Color fundus photograph.
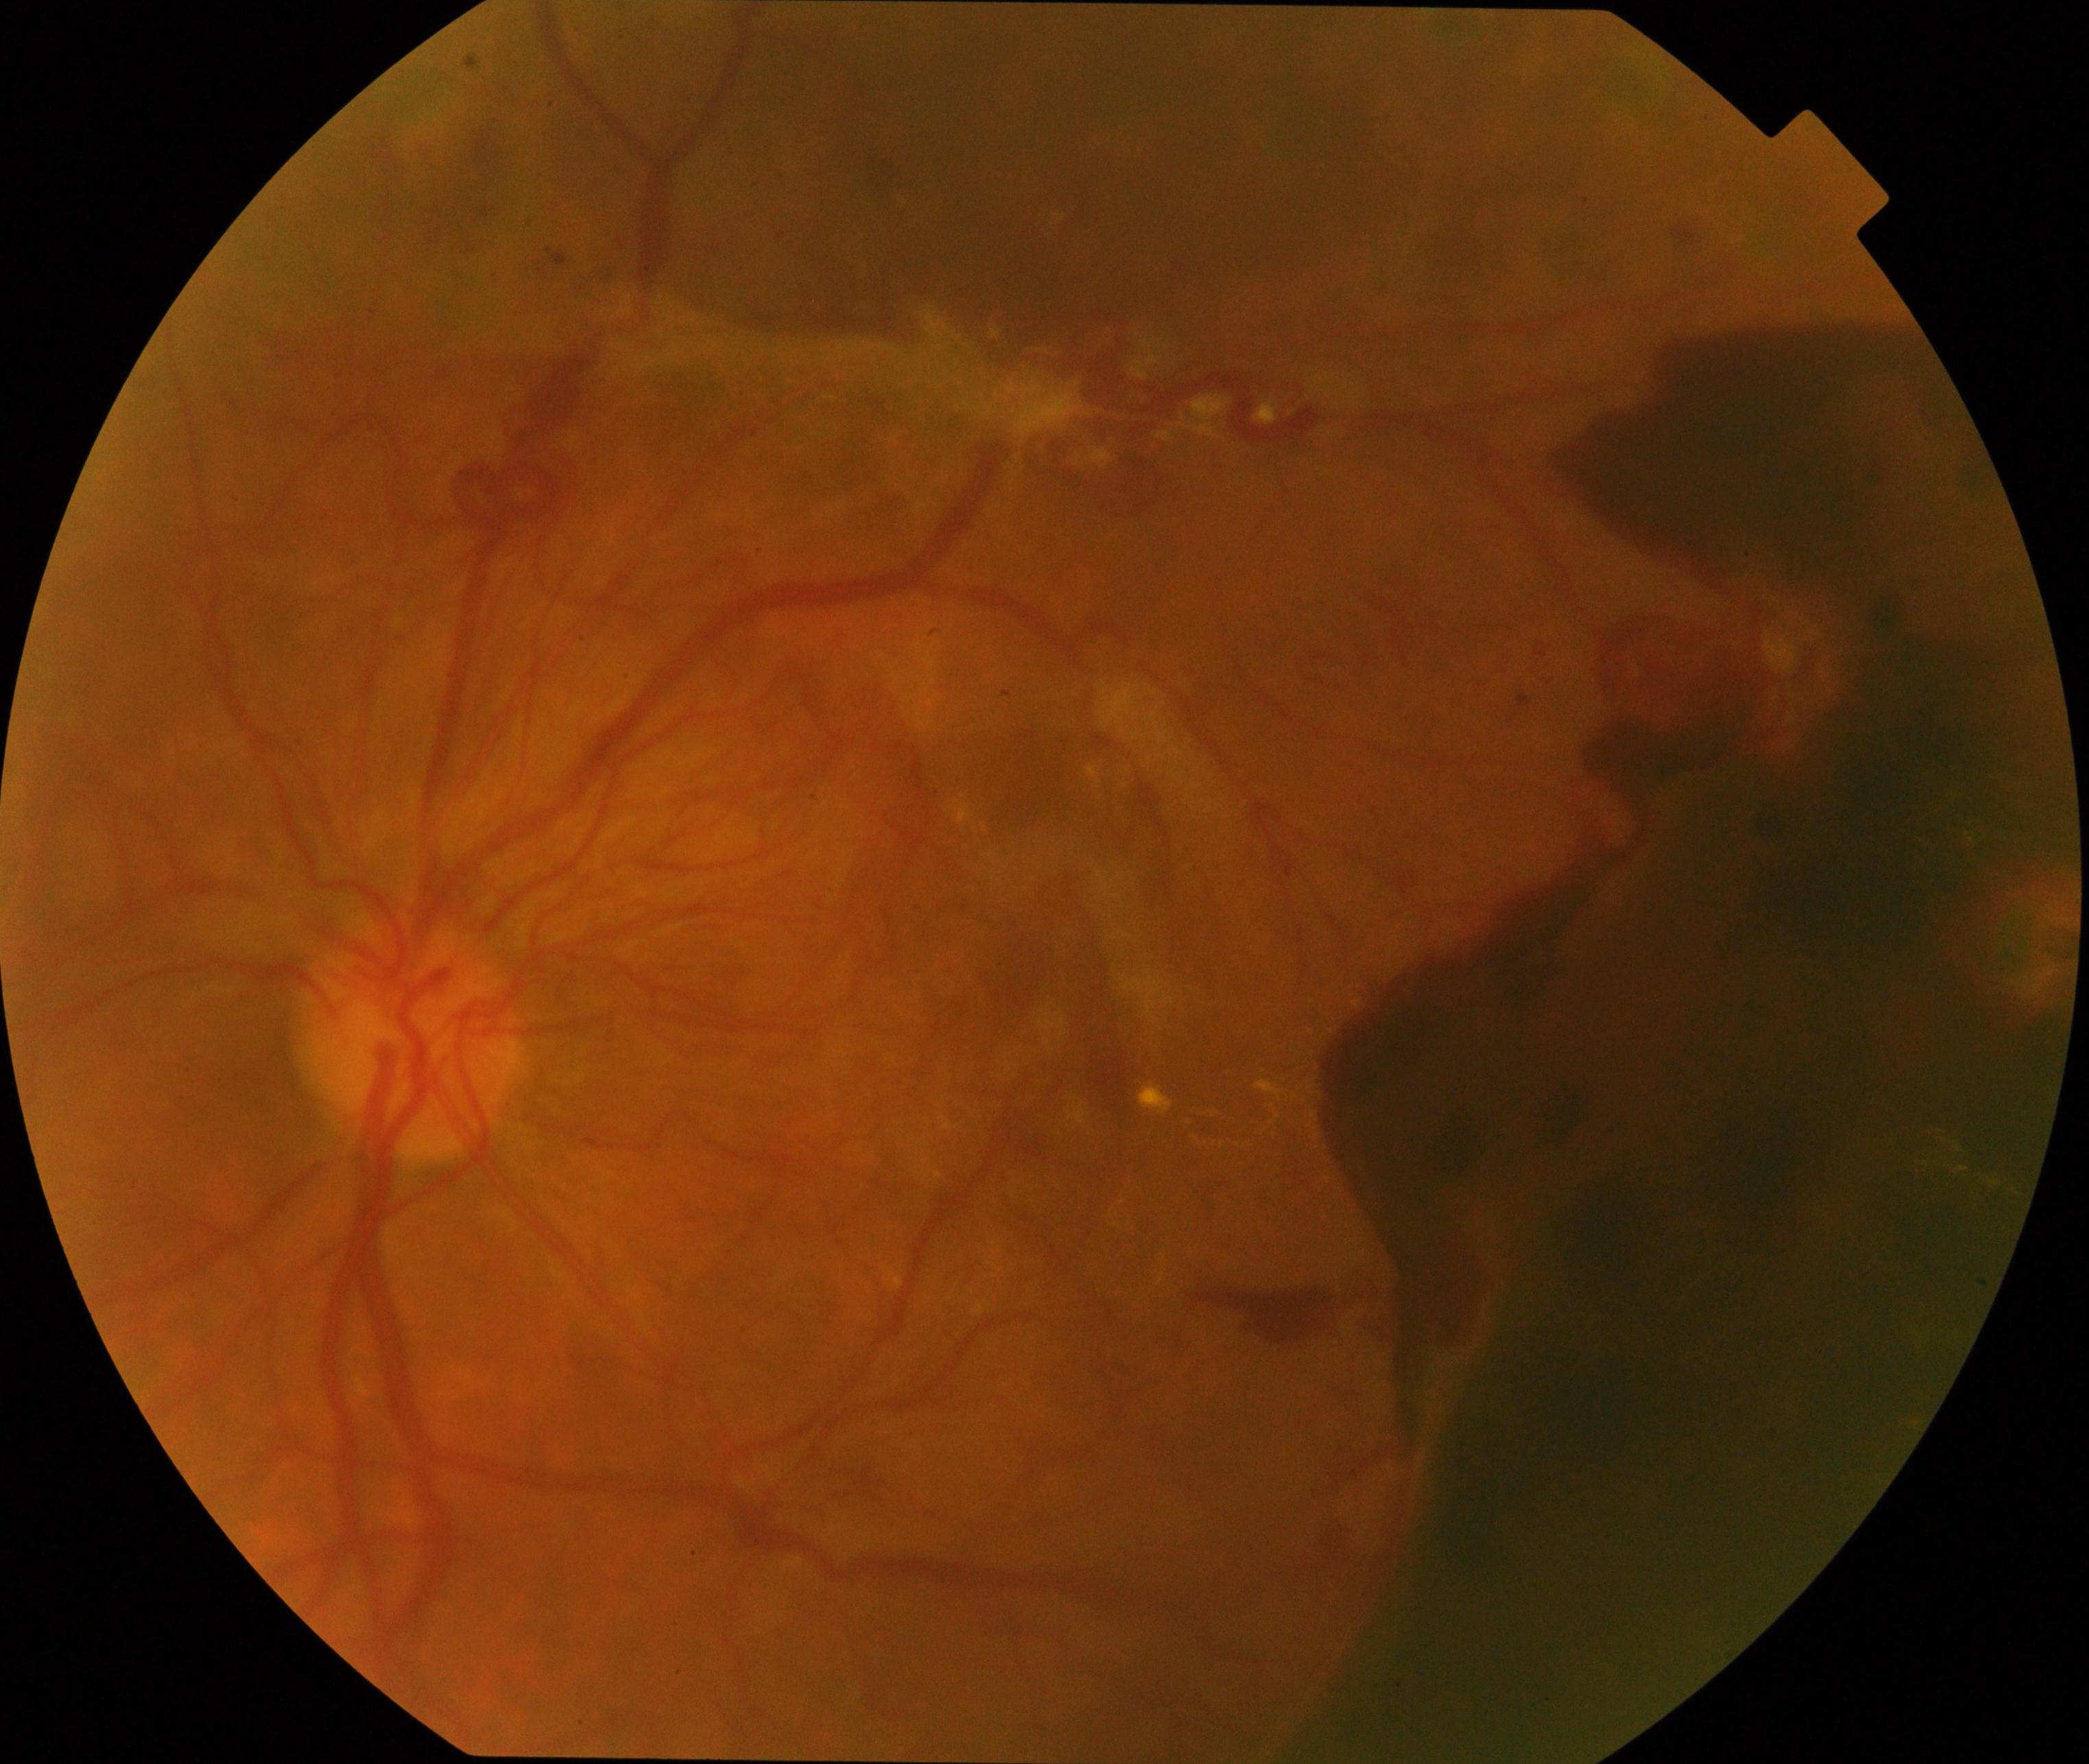 There is evidence of severe non-proliferative or proliferative diabetic retinopathy. Defined by severe non-proliferative diabetic retinopathy or proliferative diabetic retinopathy with neovascularization or vitreous/preretinal hemorrhage.